200° FOV, 1924 x 1556 pixels
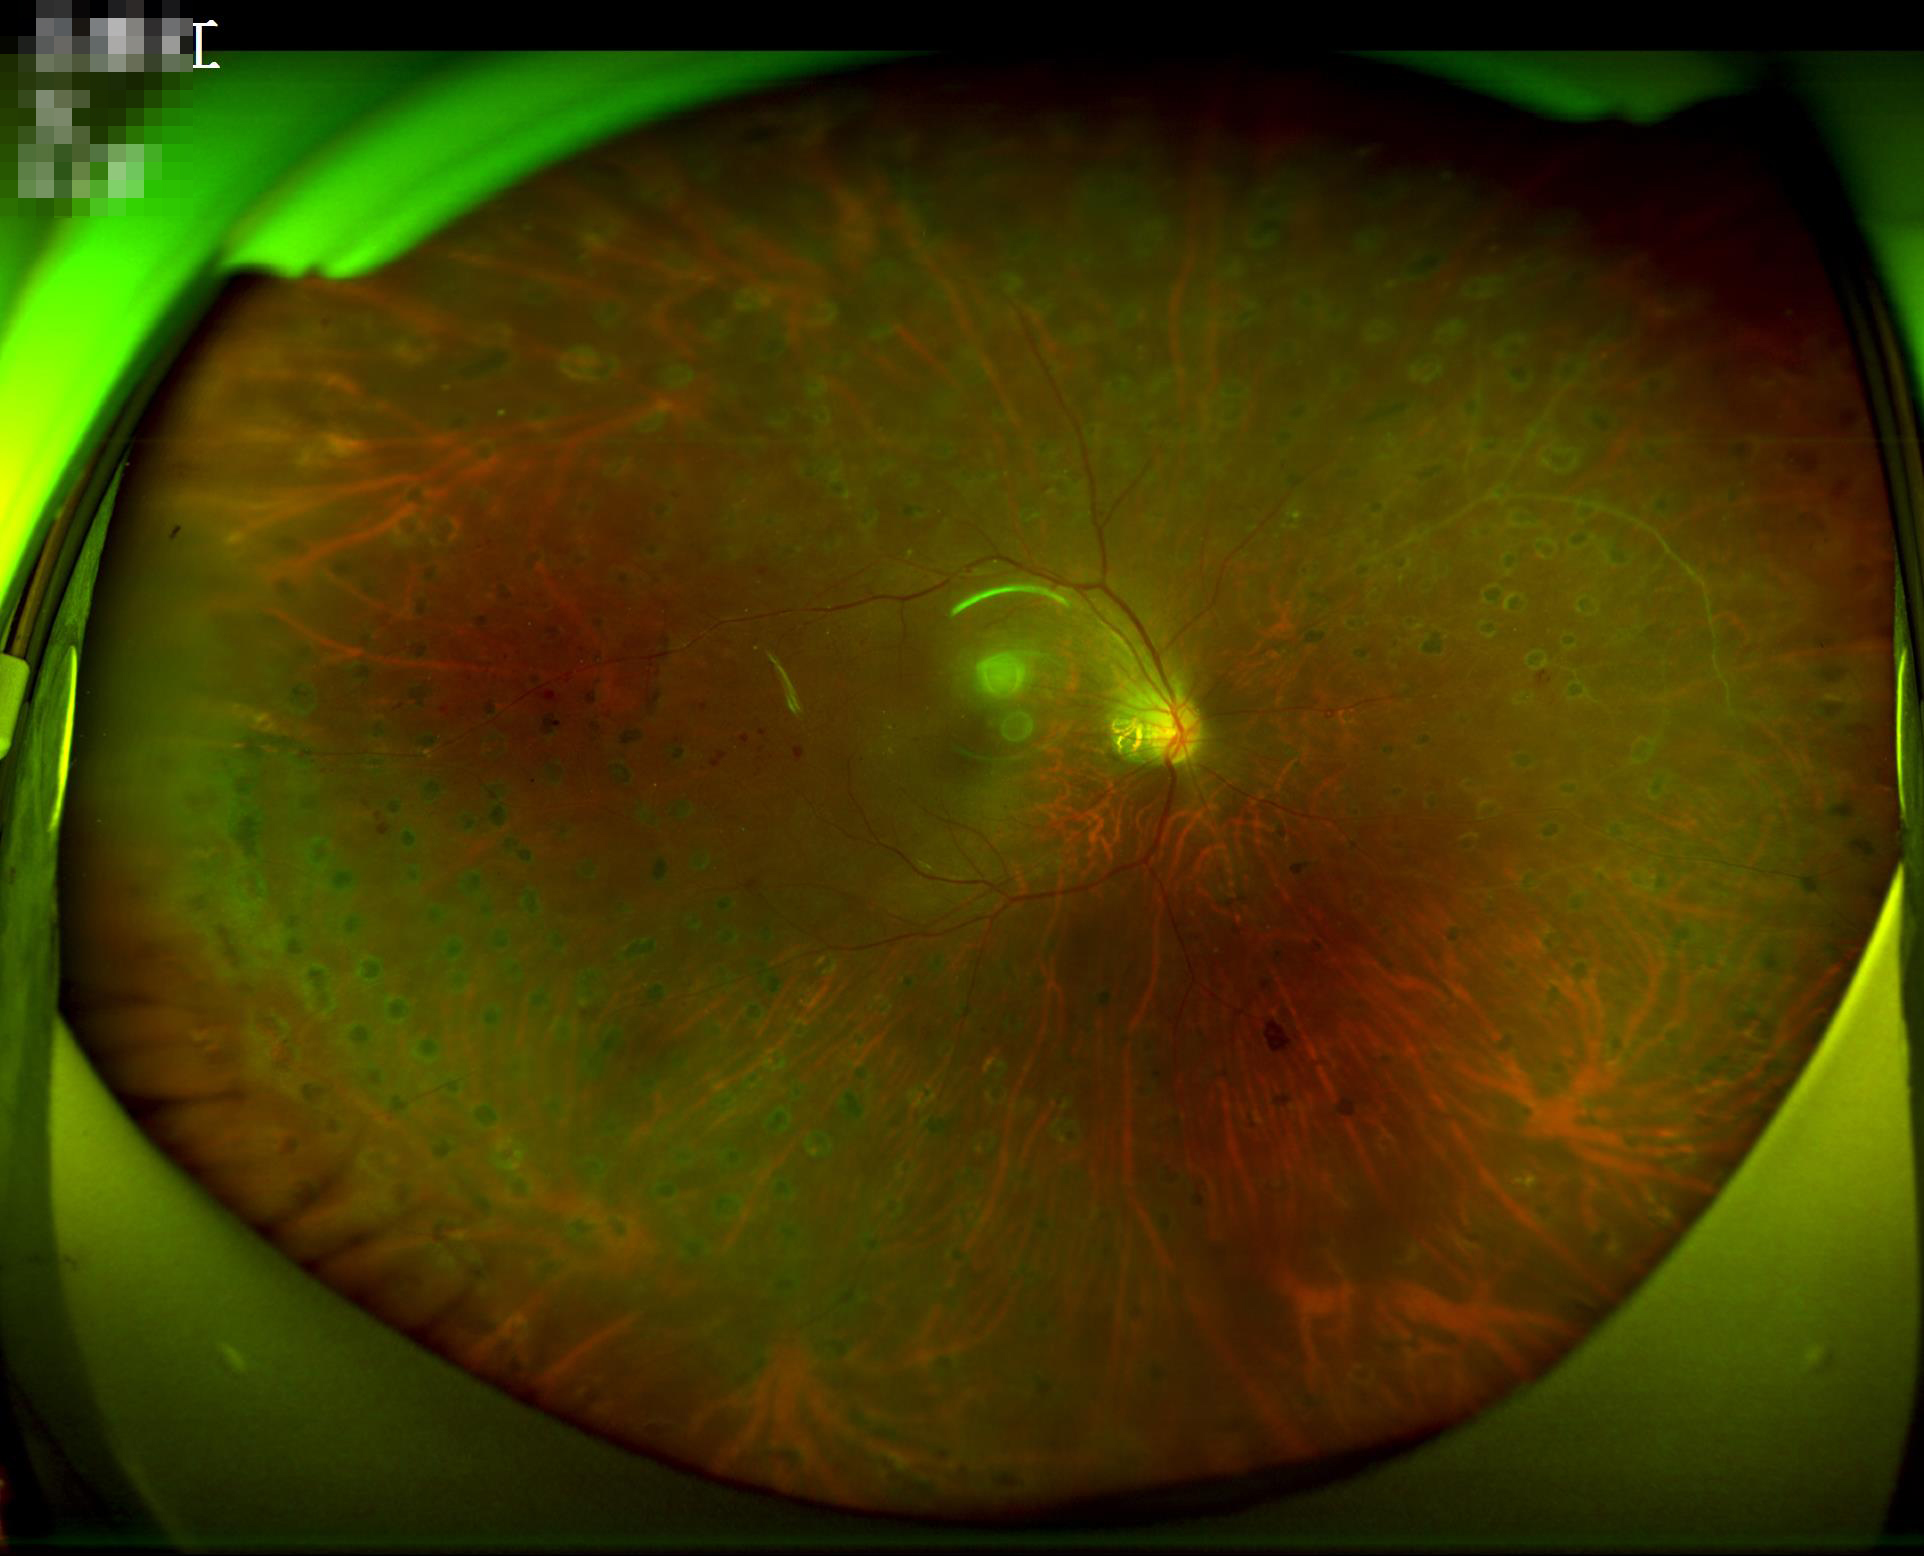 Even illumination with no color cast. Image is sharp throughout the field. Good dynamic range. Overall quality is good and the image is gradable.